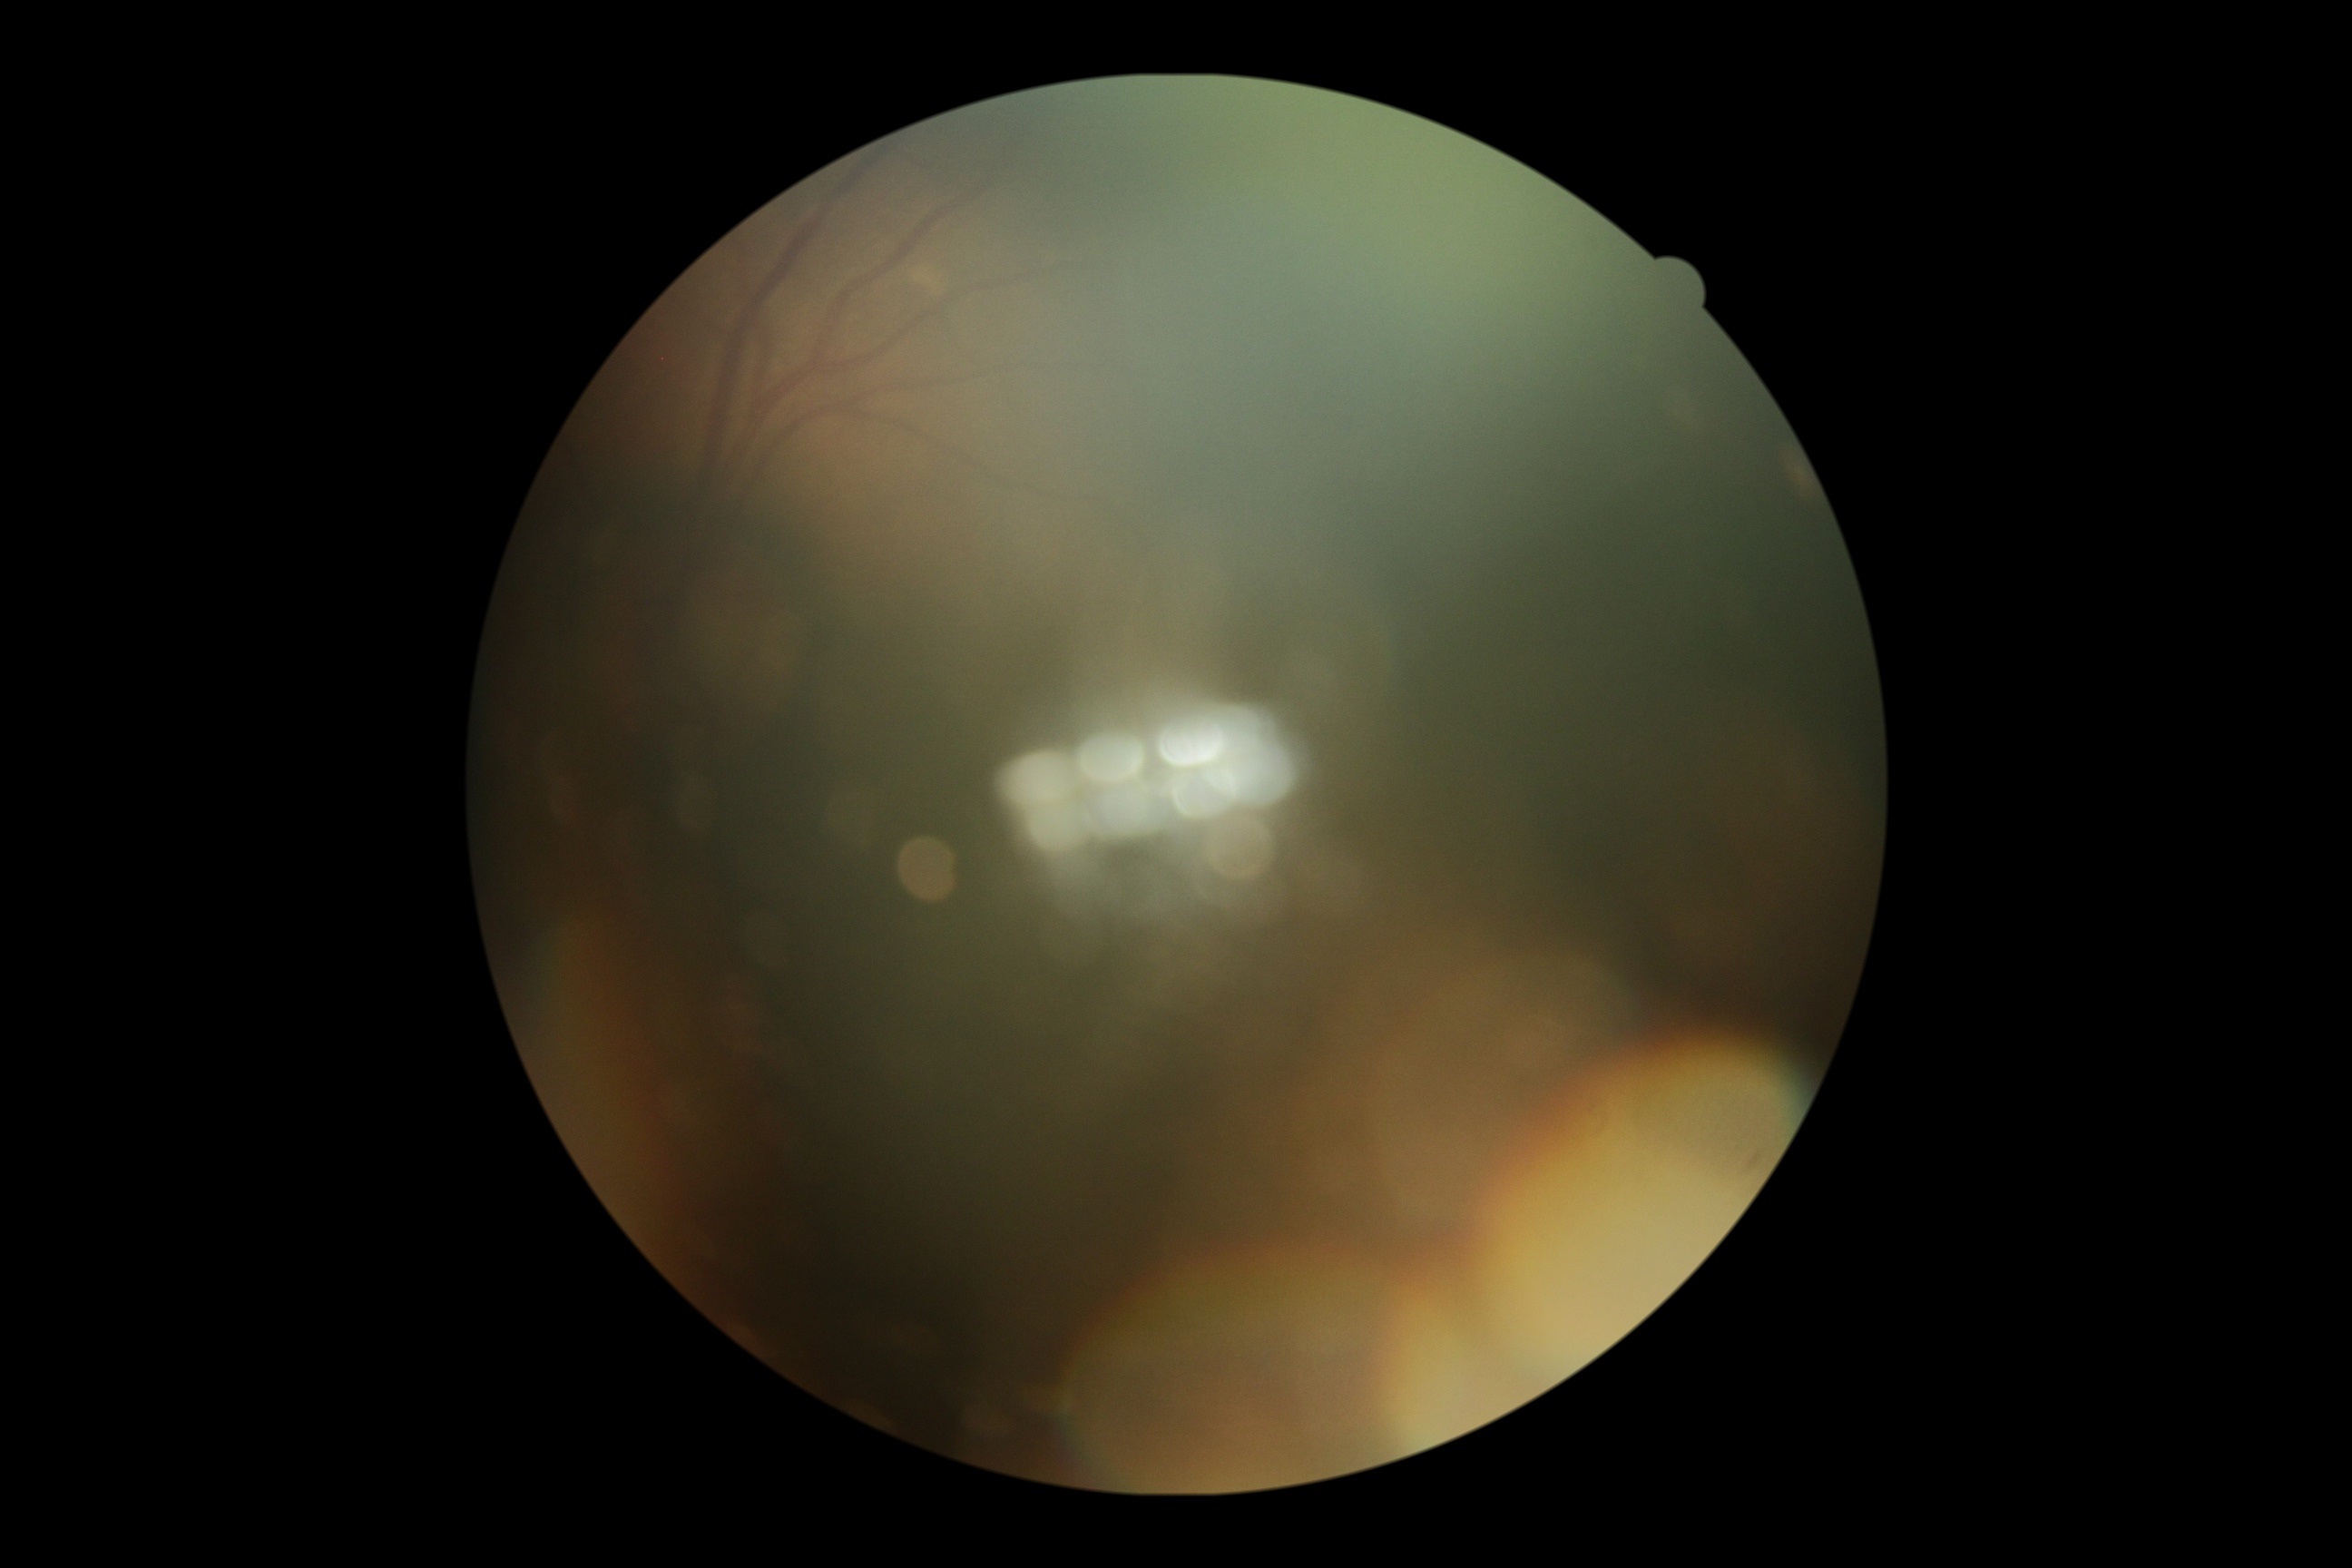 – image quality: below grading threshold
– diabetic retinopathy (DR): ungradable